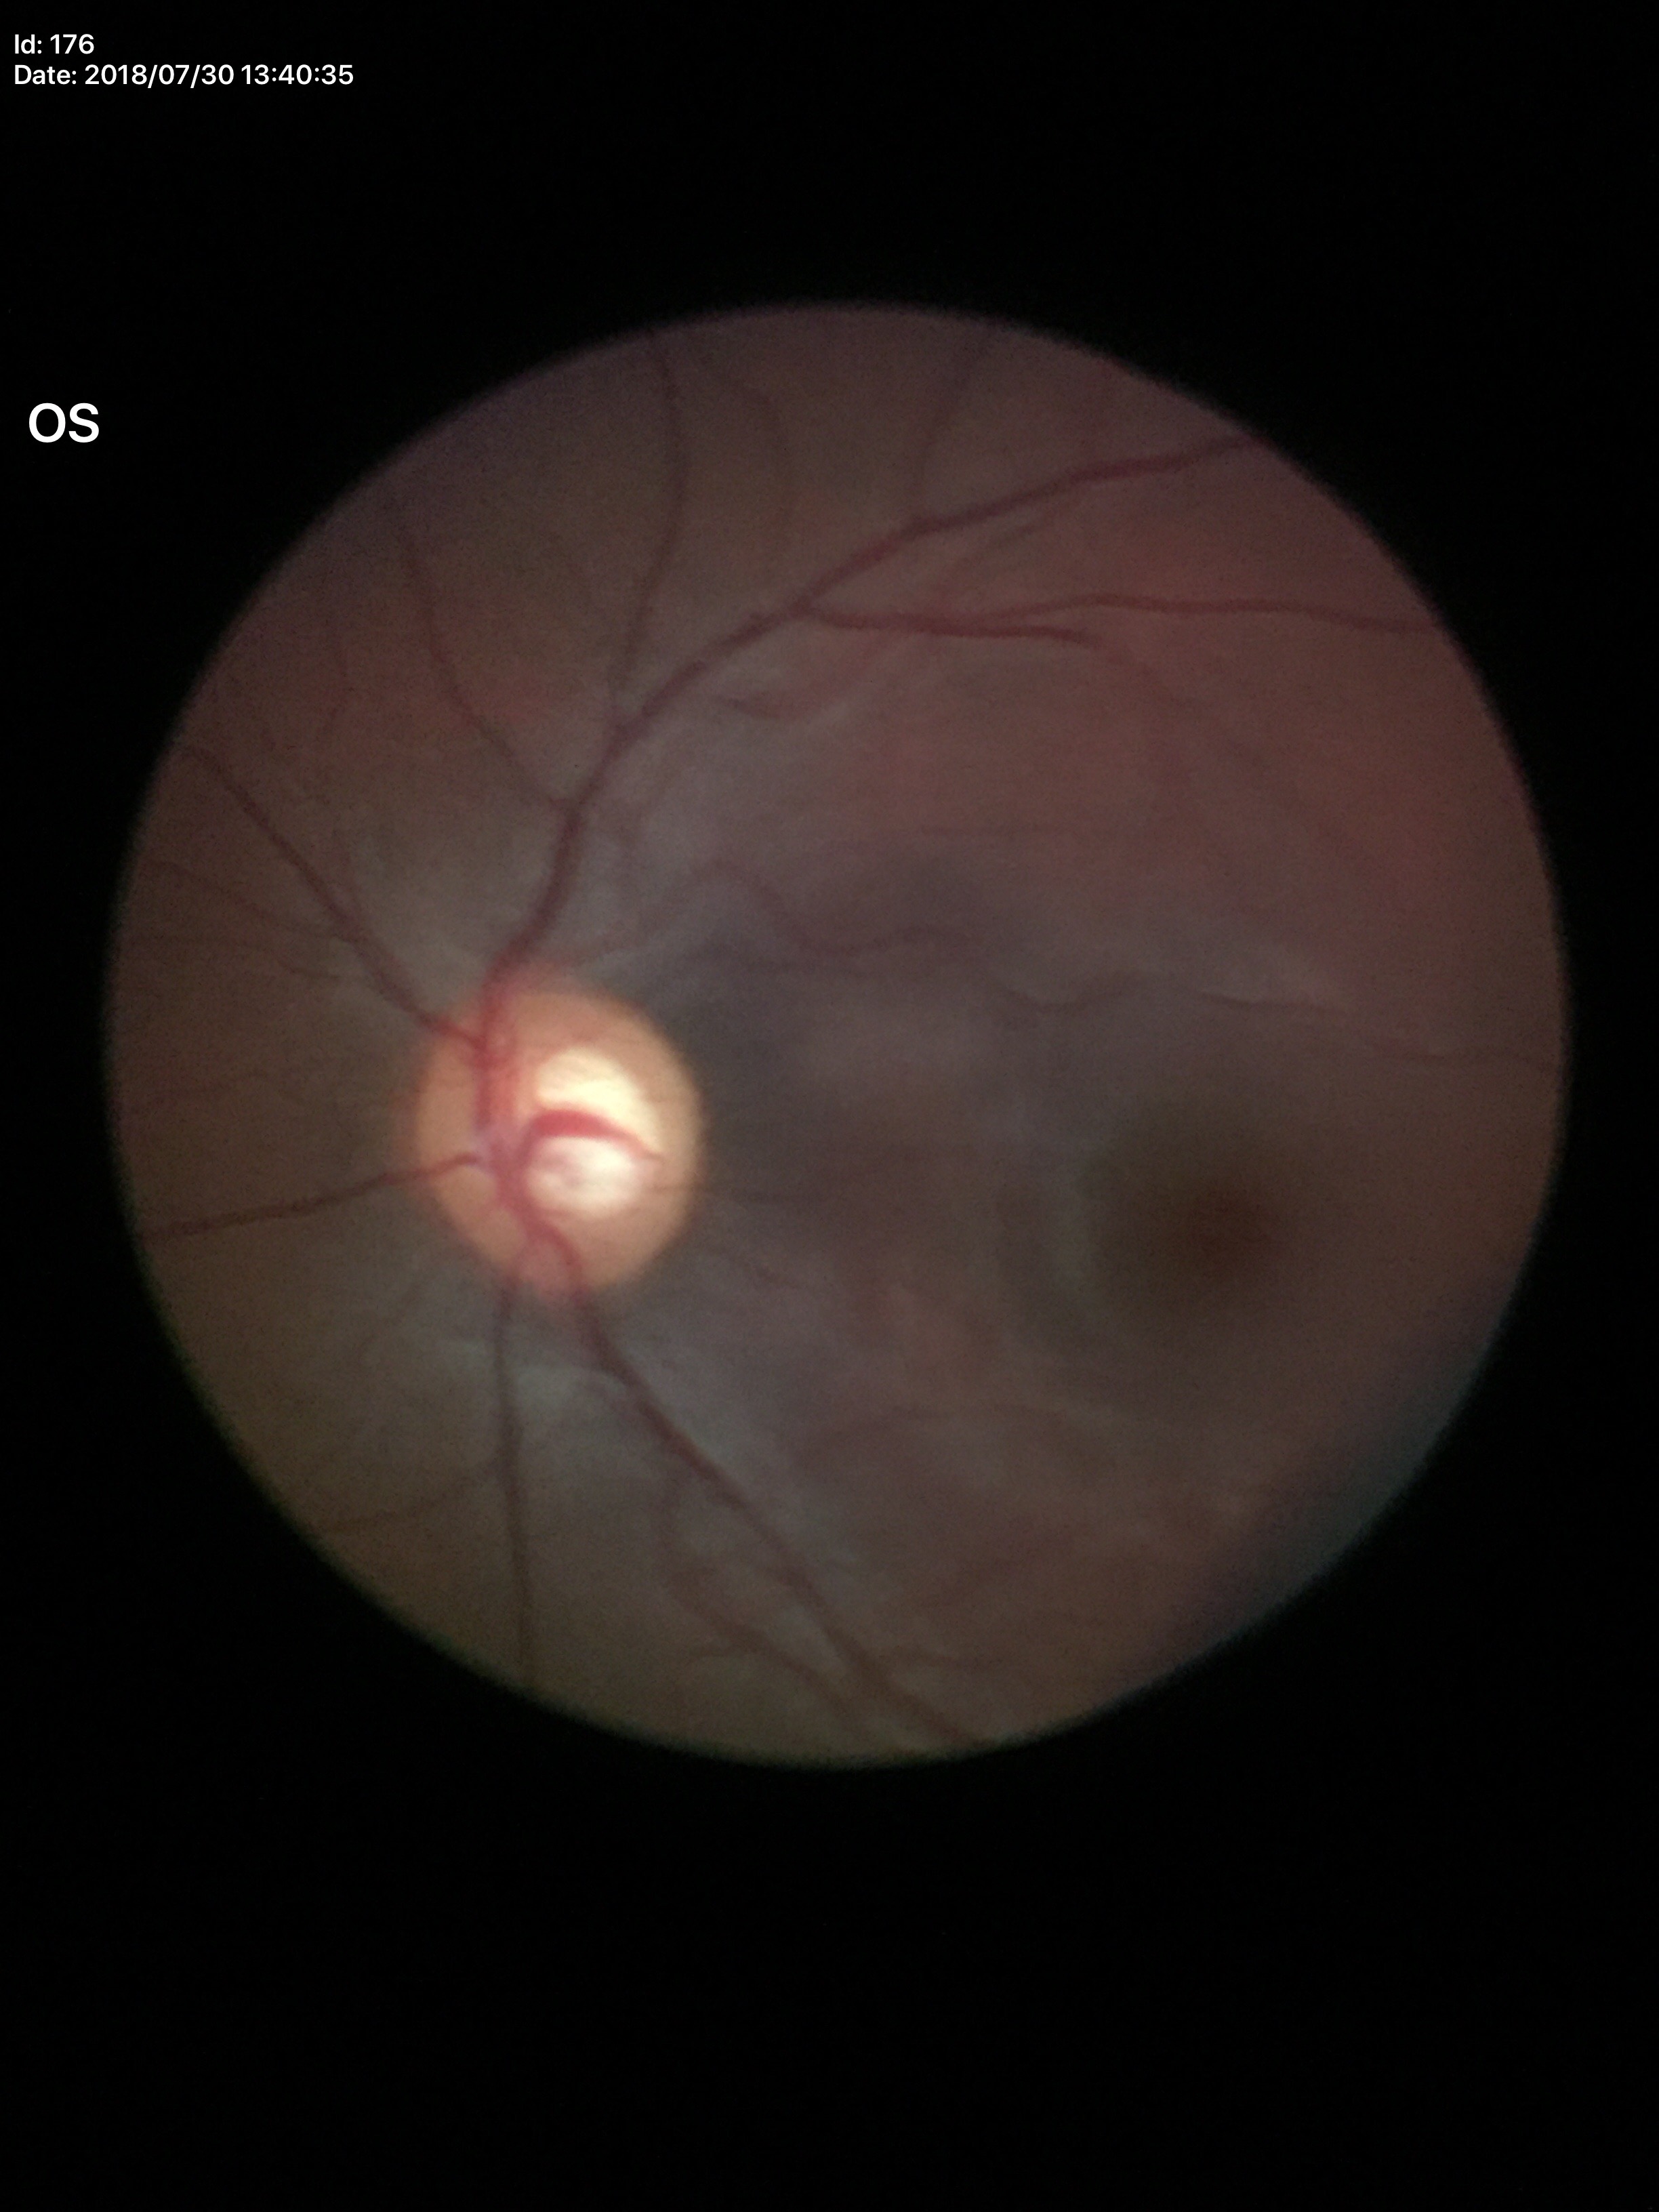
Horizontal cup-to-disc ratio: 0.64. Vertical cup-disc ratio is 0.63. Glaucoma suspect (4 of 5 graders flagged glaucoma suspect).